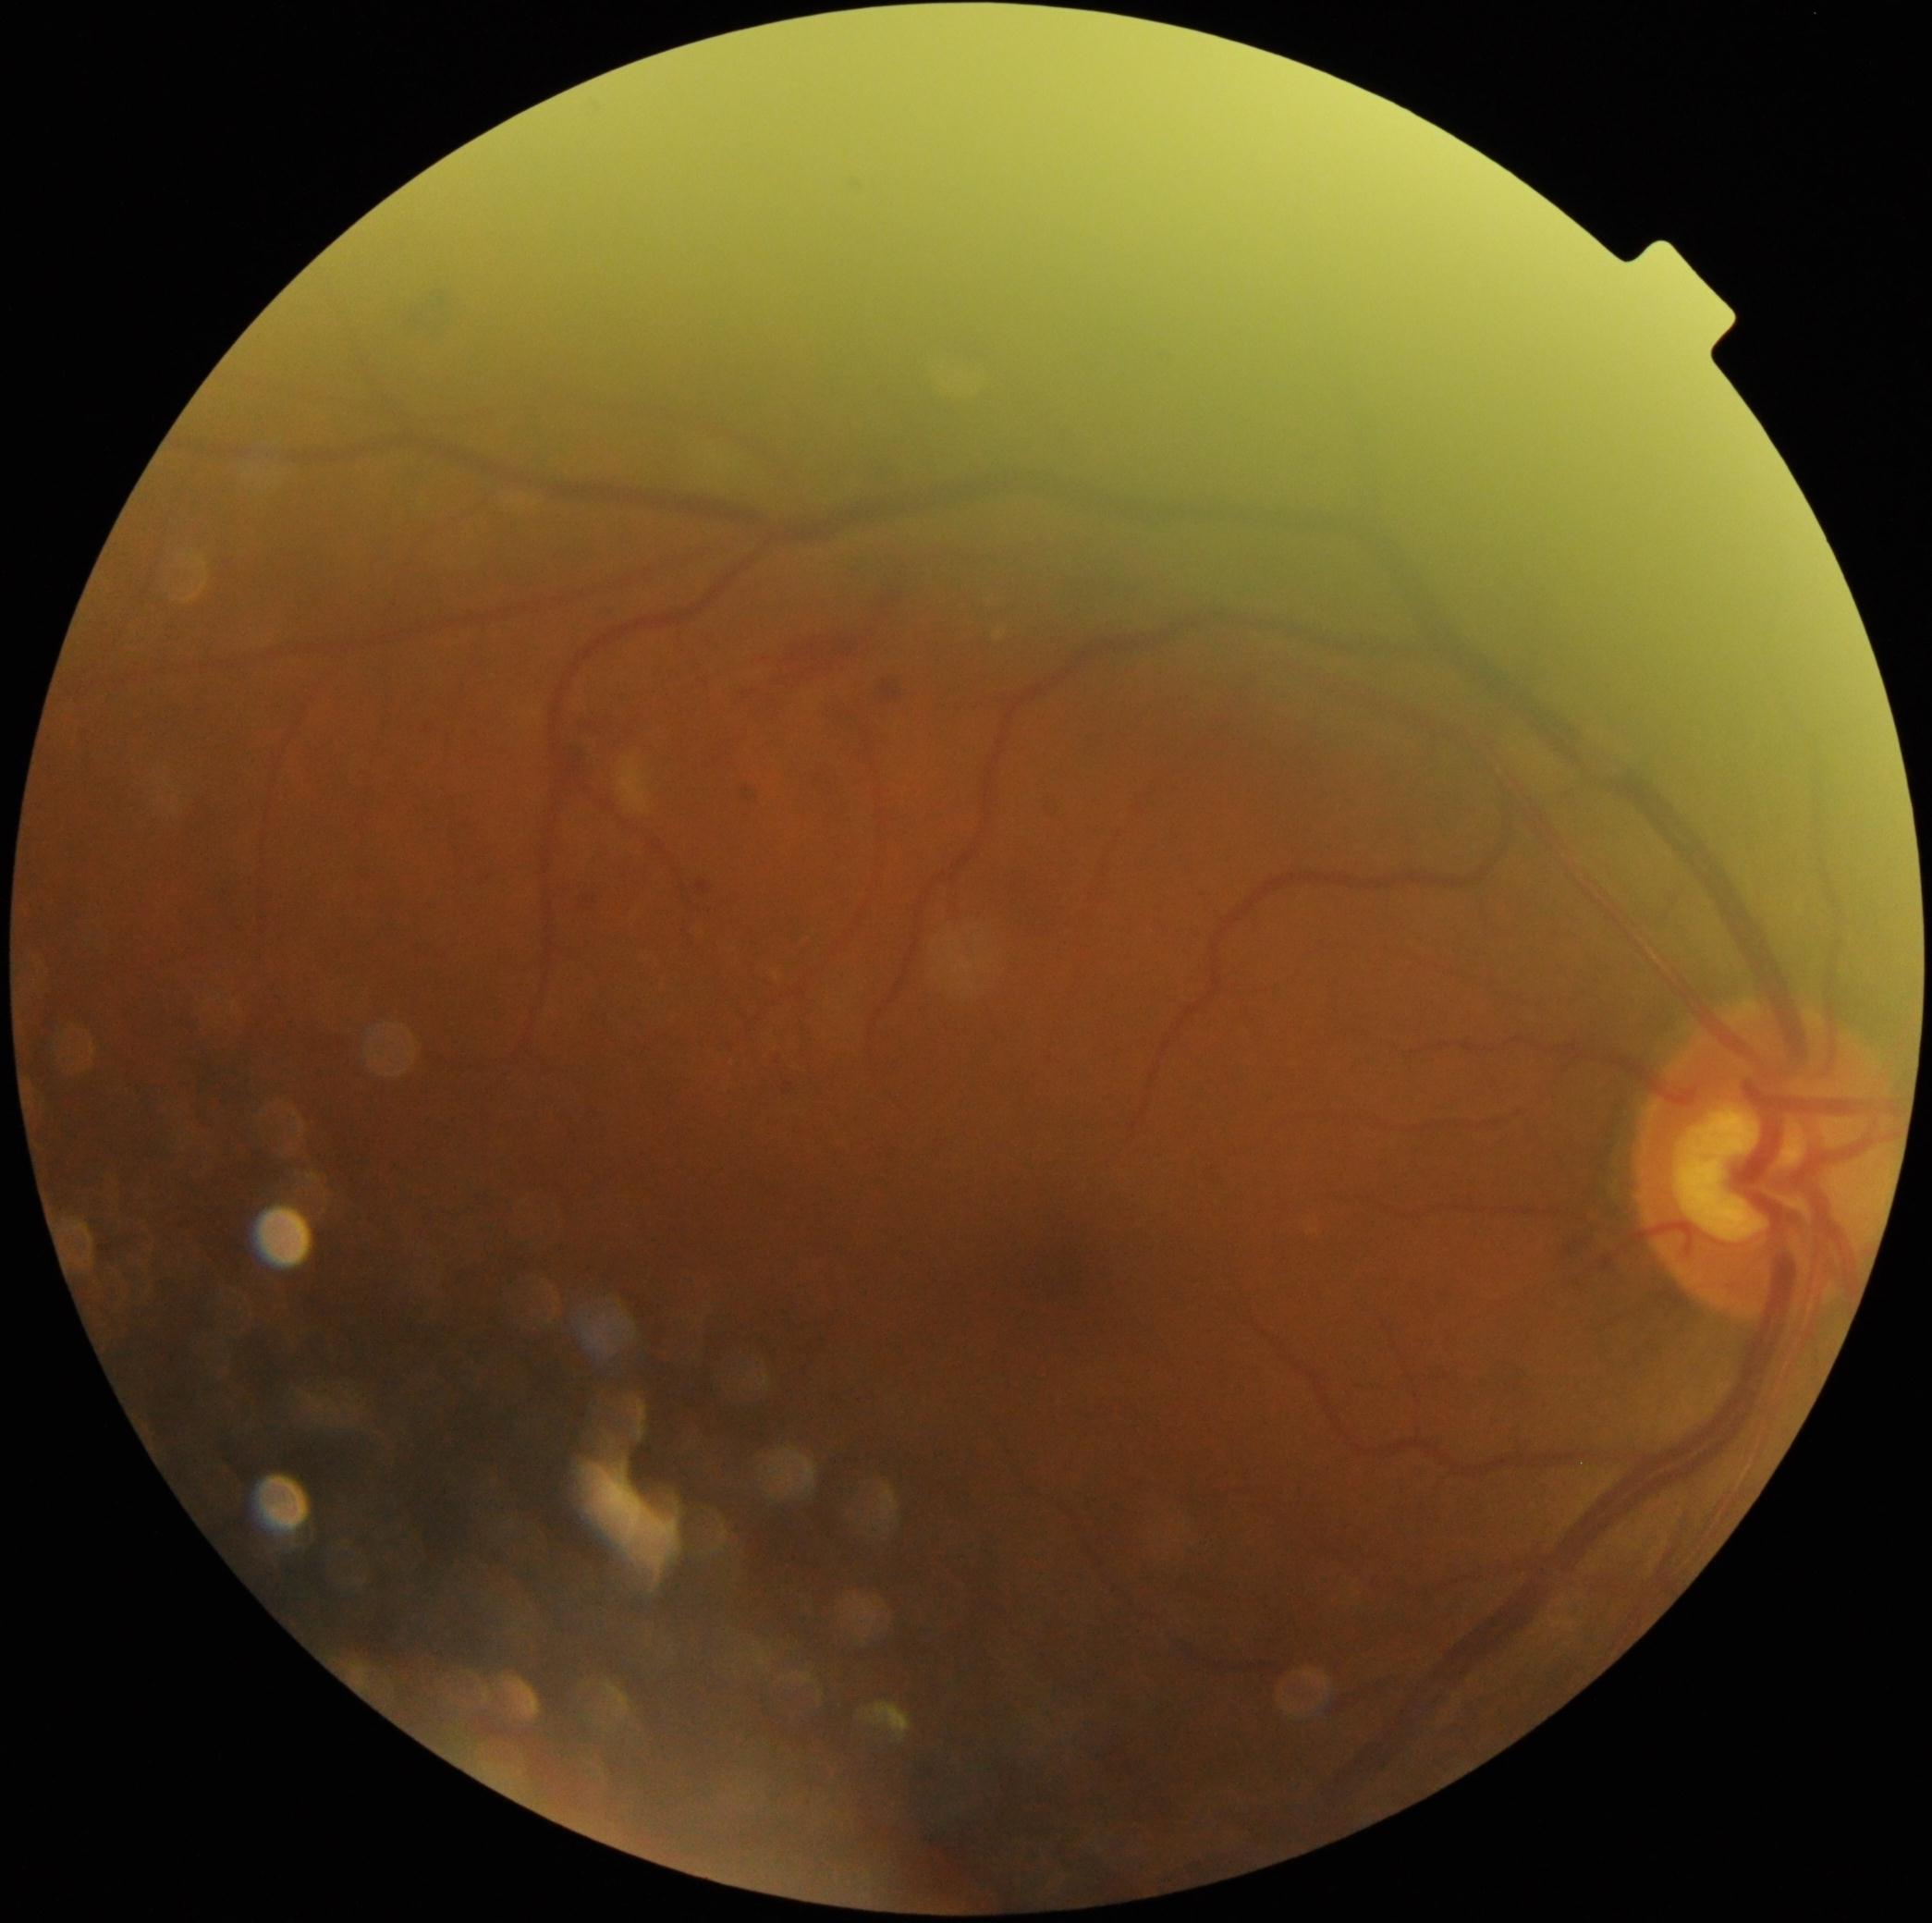
Diabetic retinopathy grade: 2 (moderate NPDR).